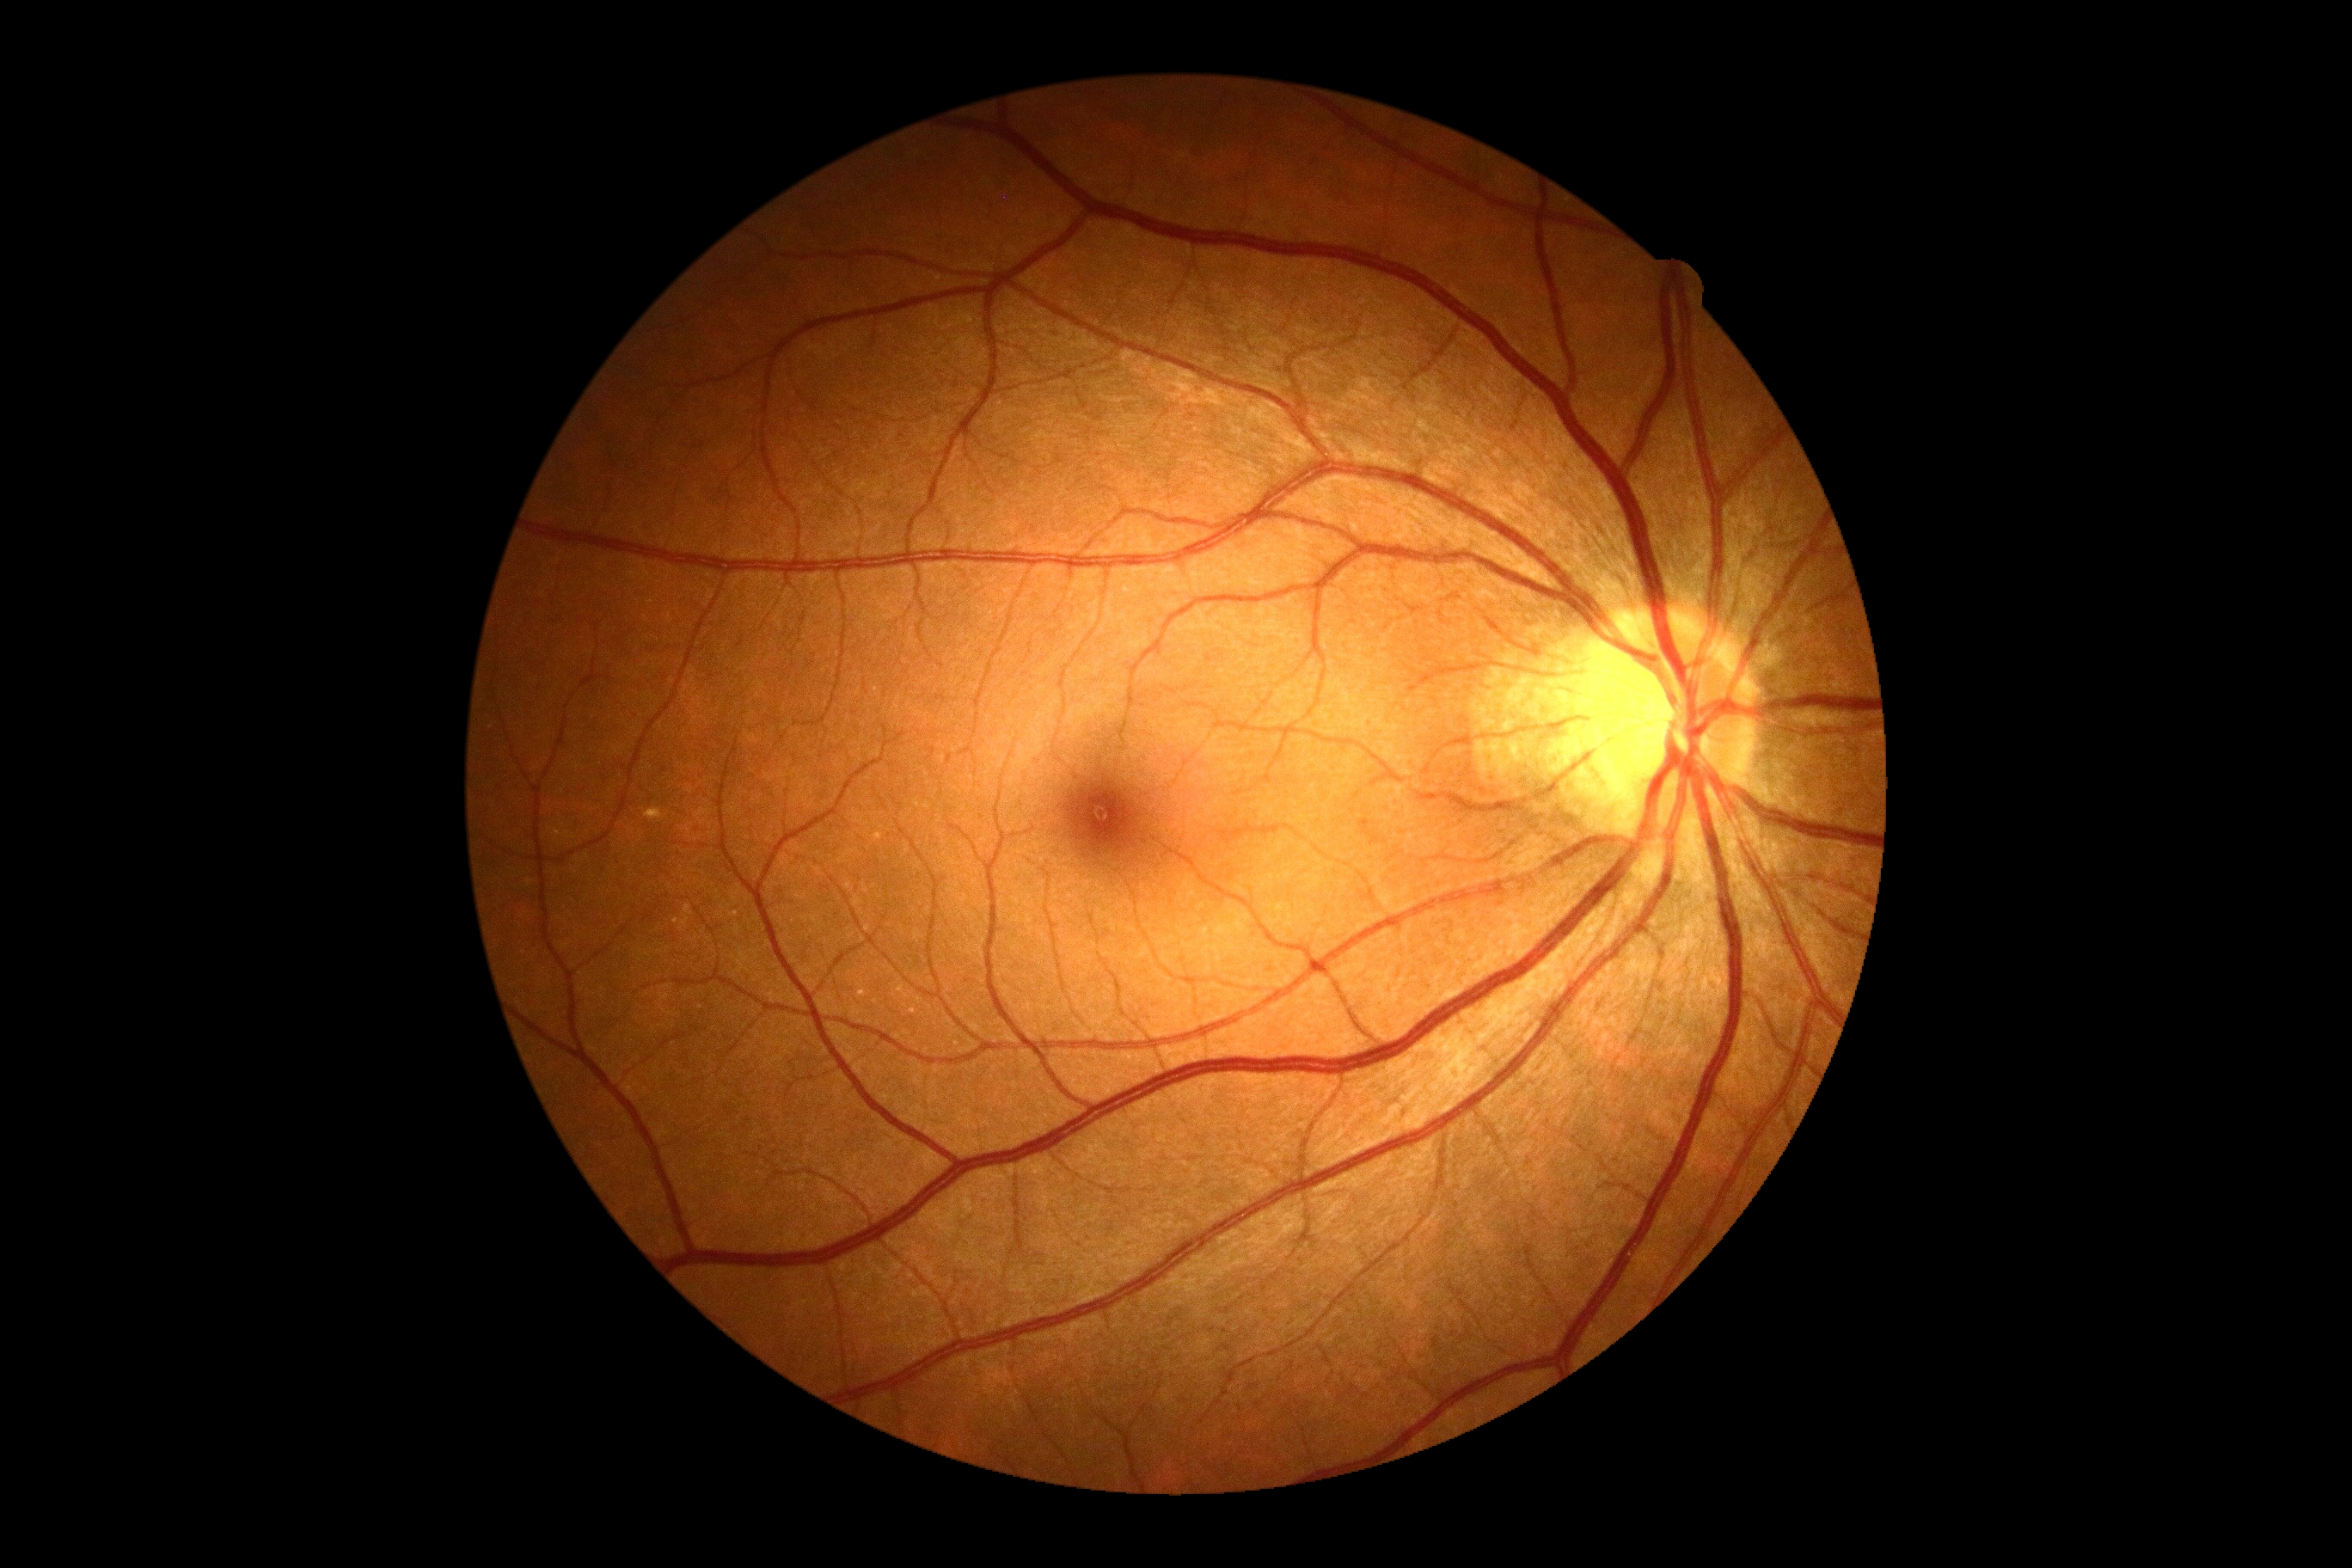
Diabetic retinopathy (DR) is grade 0 (no apparent retinopathy).
No apparent diabetic retinopathy.